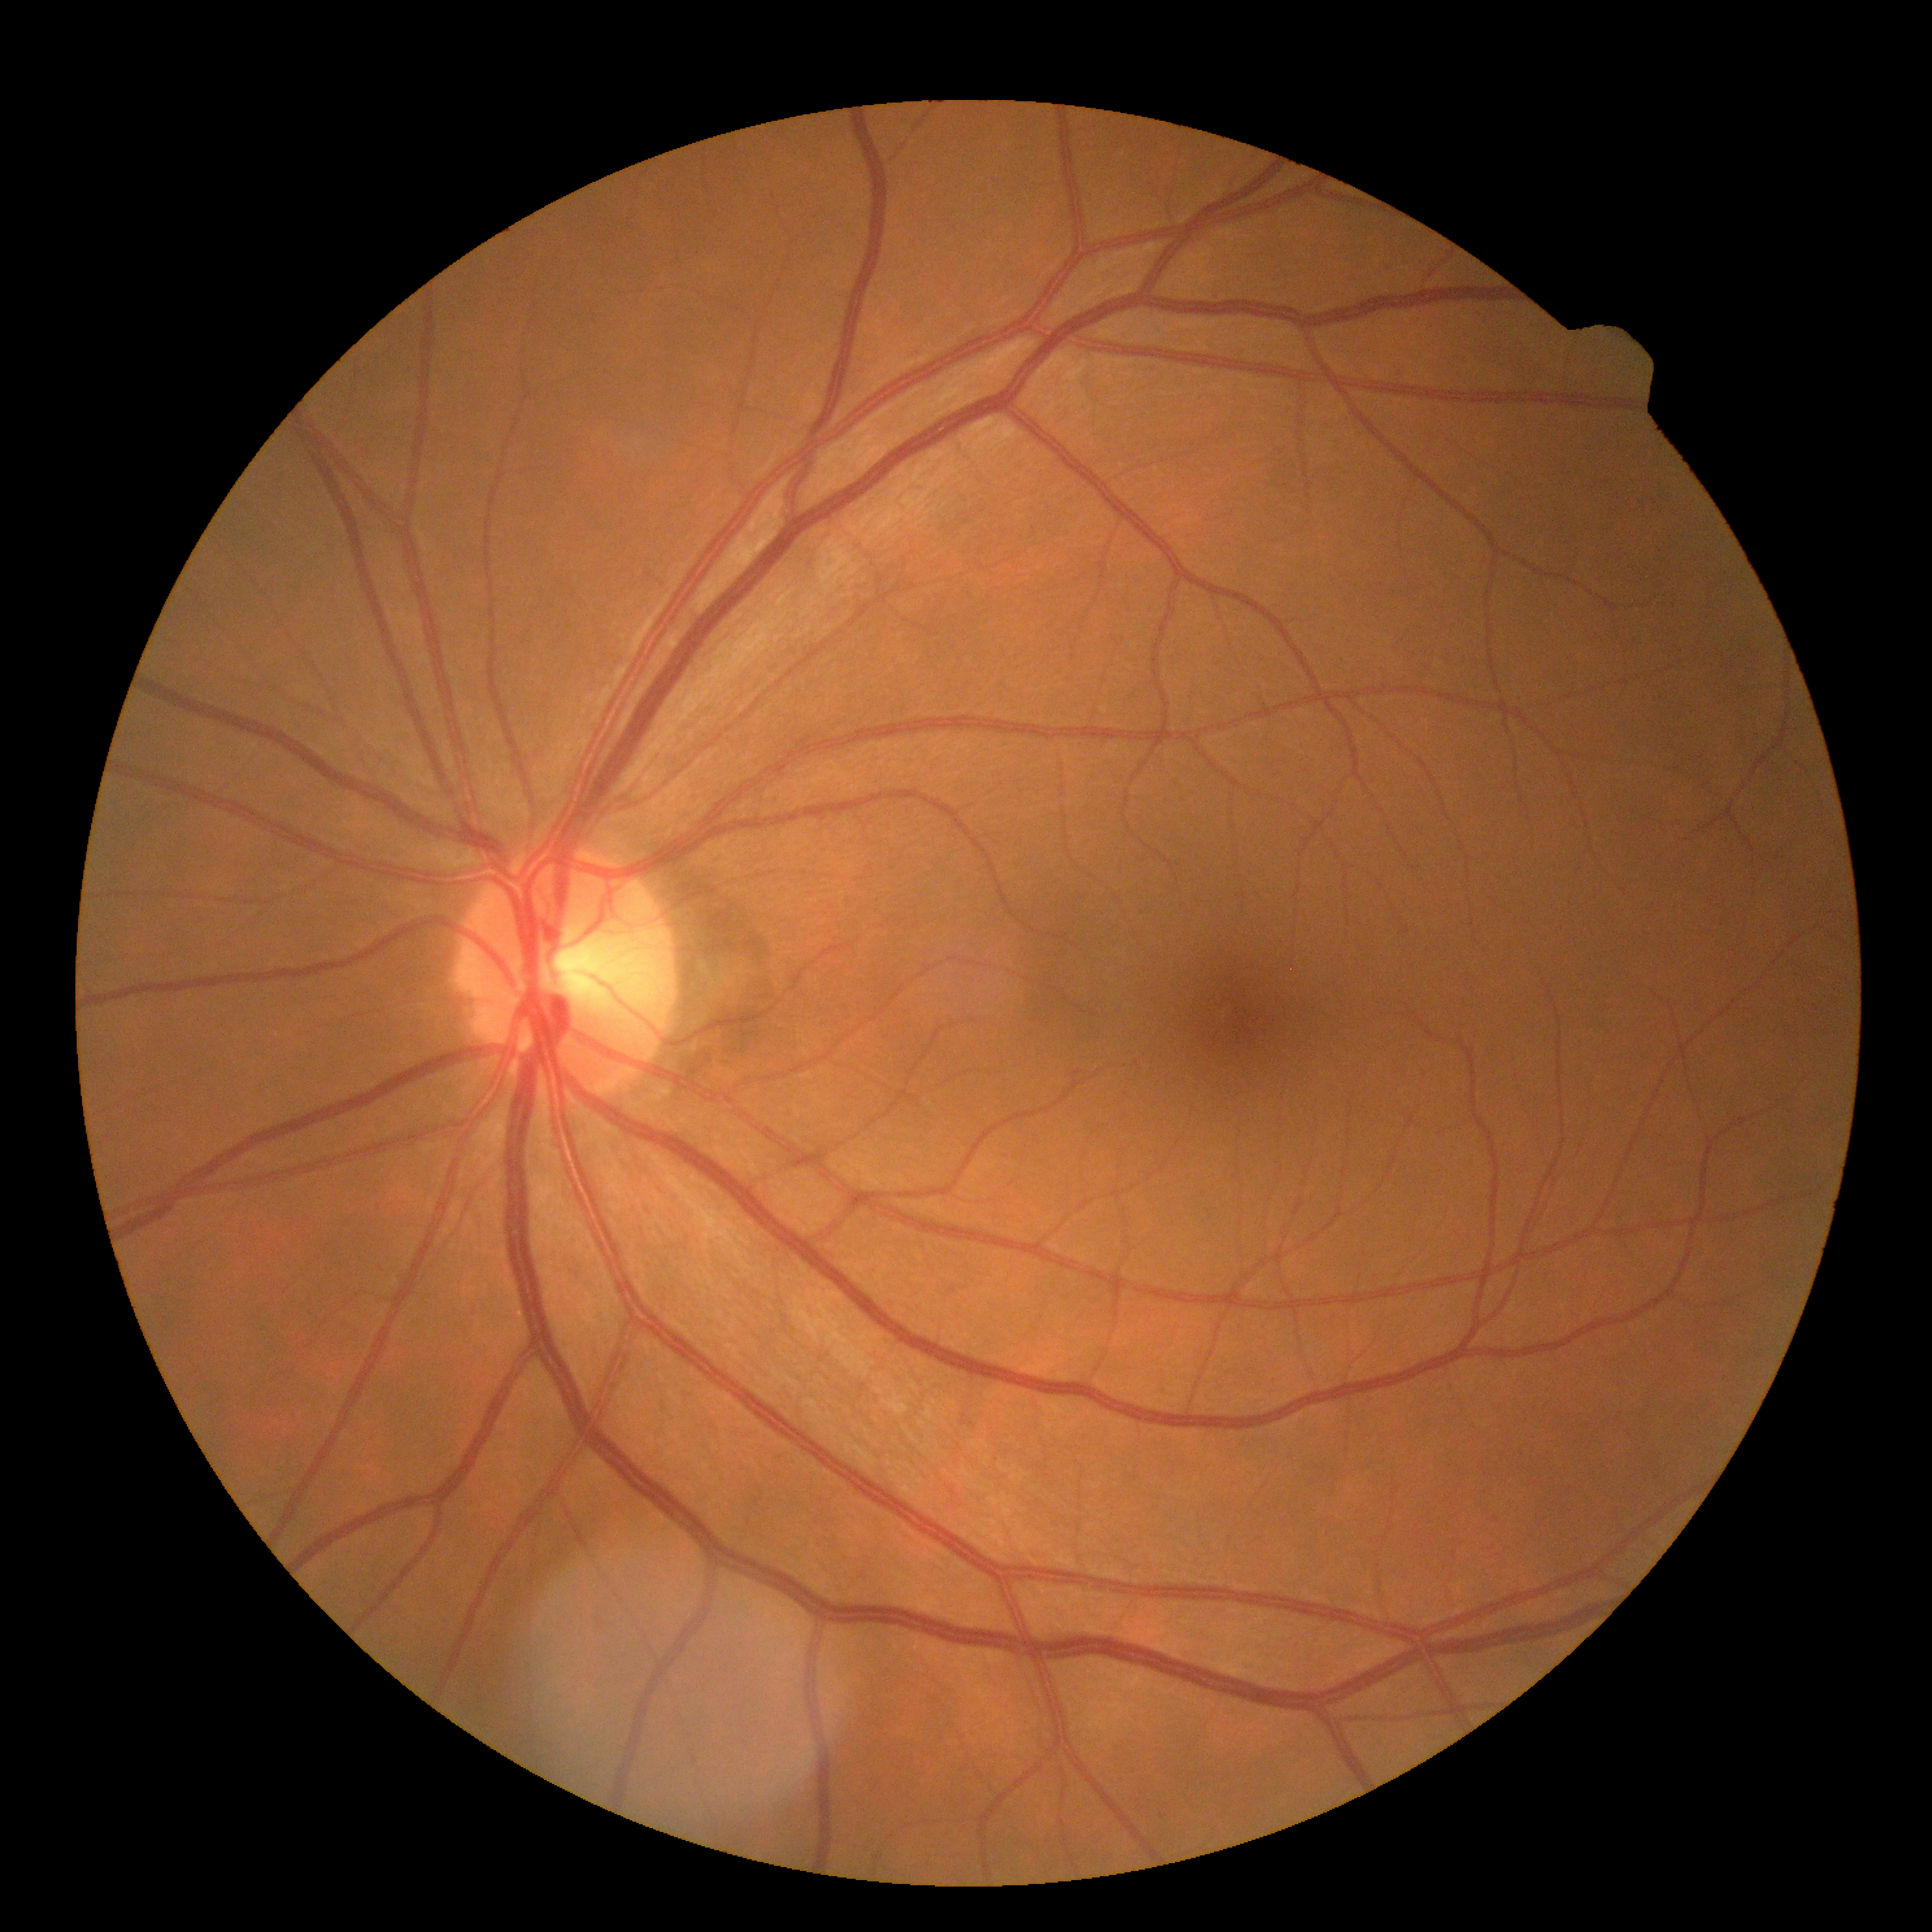

Diabetic retinopathy (DR): 0 — no visible signs of diabetic retinopathy.